NIDEK AFC-230 fundus camera, no pharmacologic dilation
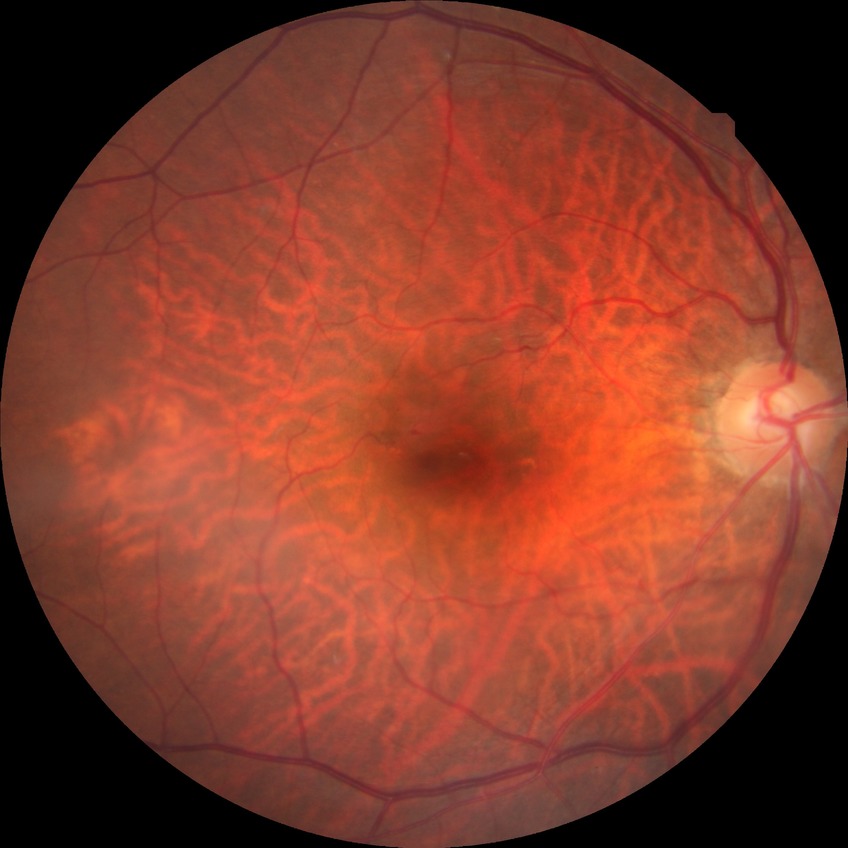
Annotations:
• DR class — non-proliferative diabetic retinopathy
• diabetic retinopathy stage — simple diabetic retinopathy